Captured on a Nidek AFC-330 fundus camera: 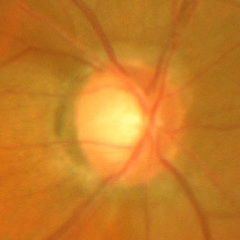

Findings consistent with glaucoma. Glaucoma stage = advanced glaucomatous optic neuropathy.